Nonmydriatic
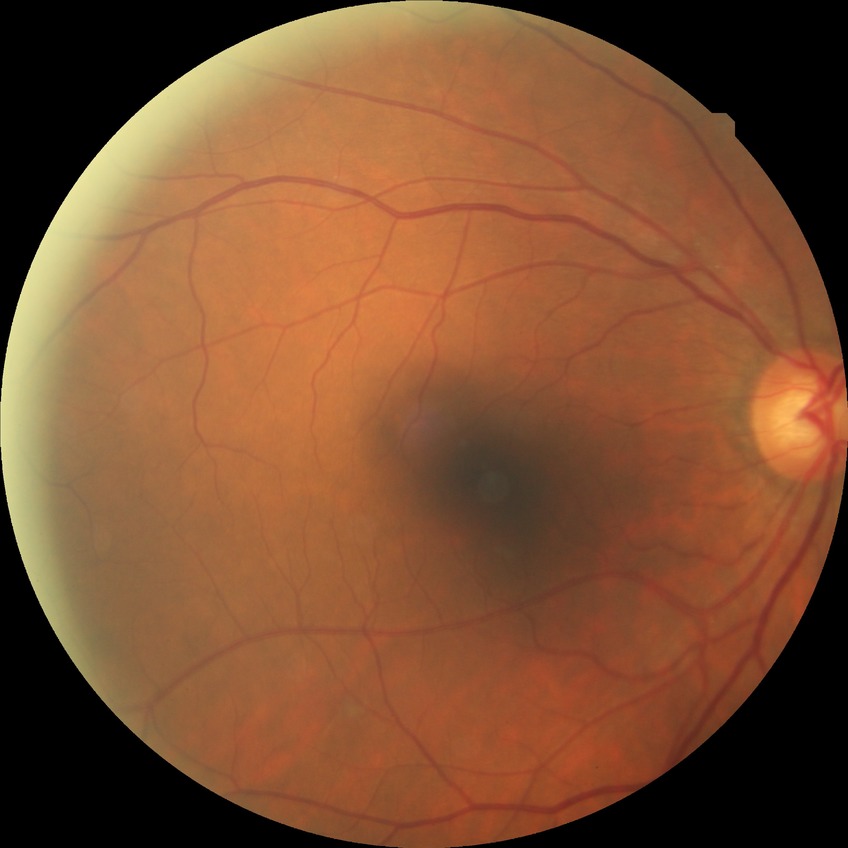

Diabetic retinopathy (DR): no diabetic retinopathy (NDR).